FOV: 50 degrees, fundus photo, captured after pupil dilation:
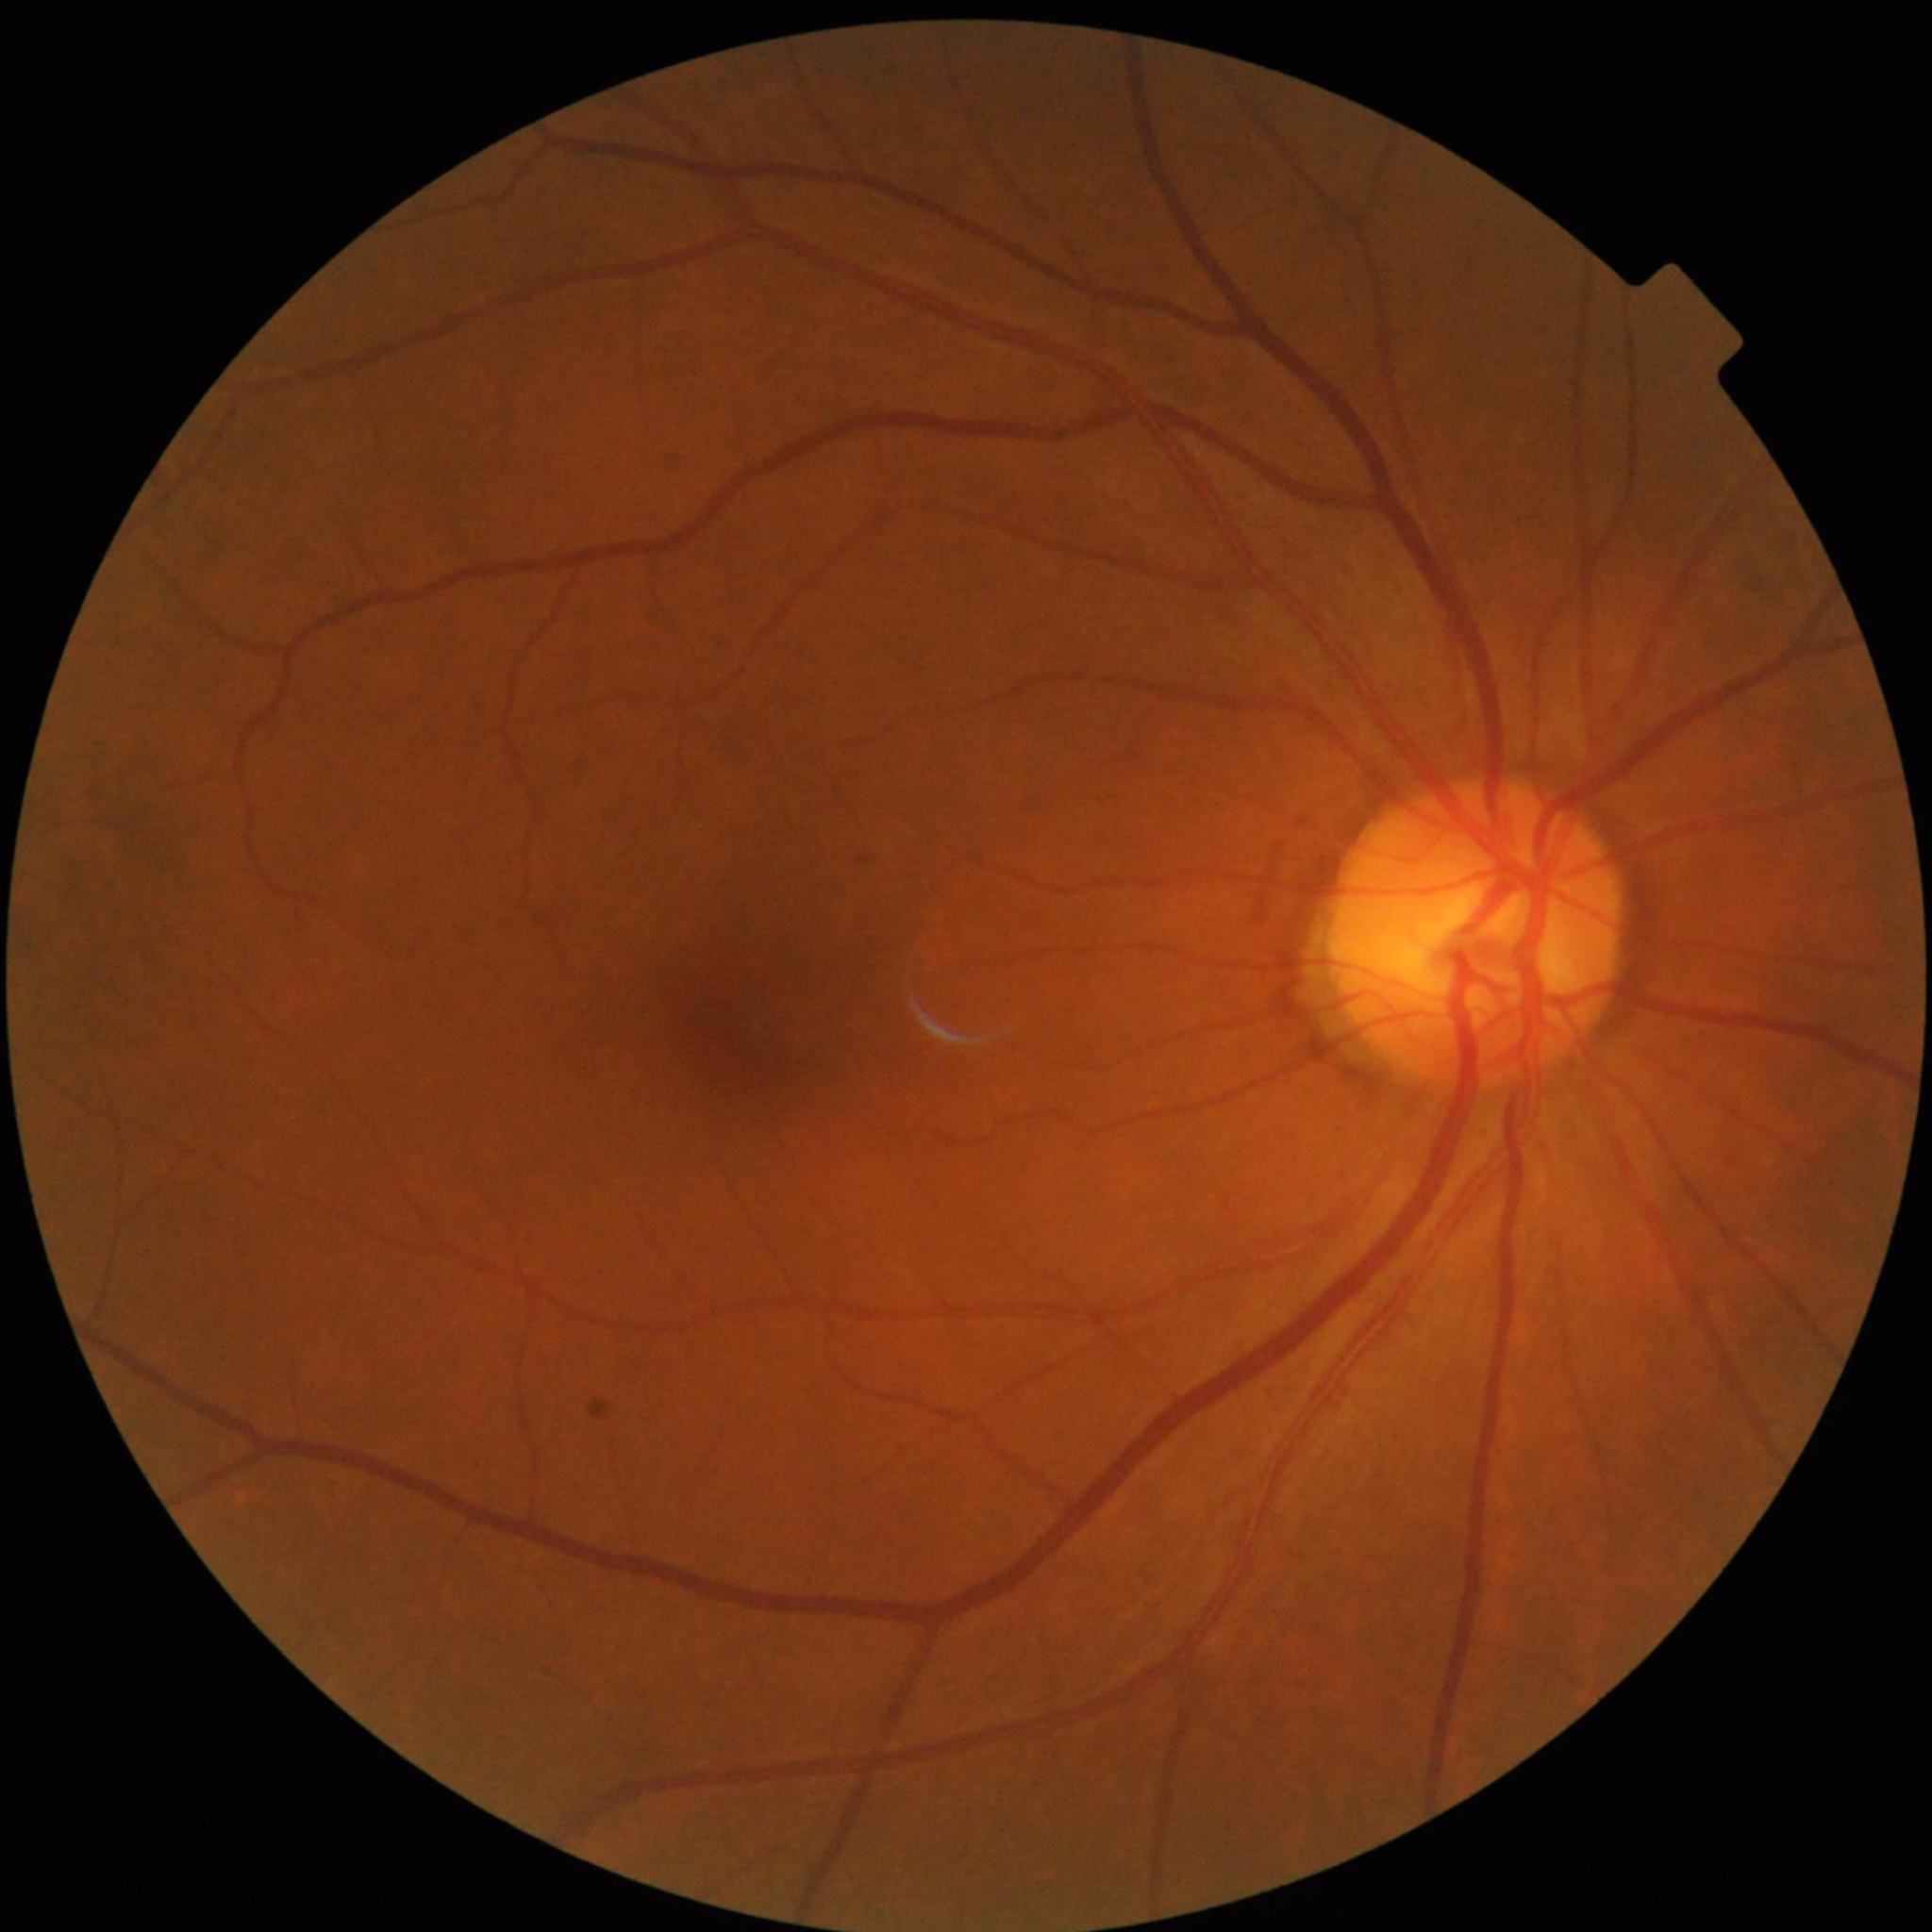
Condition: no AMD, DR, or glaucoma.